Retinal fundus photograph; 2352x1568px
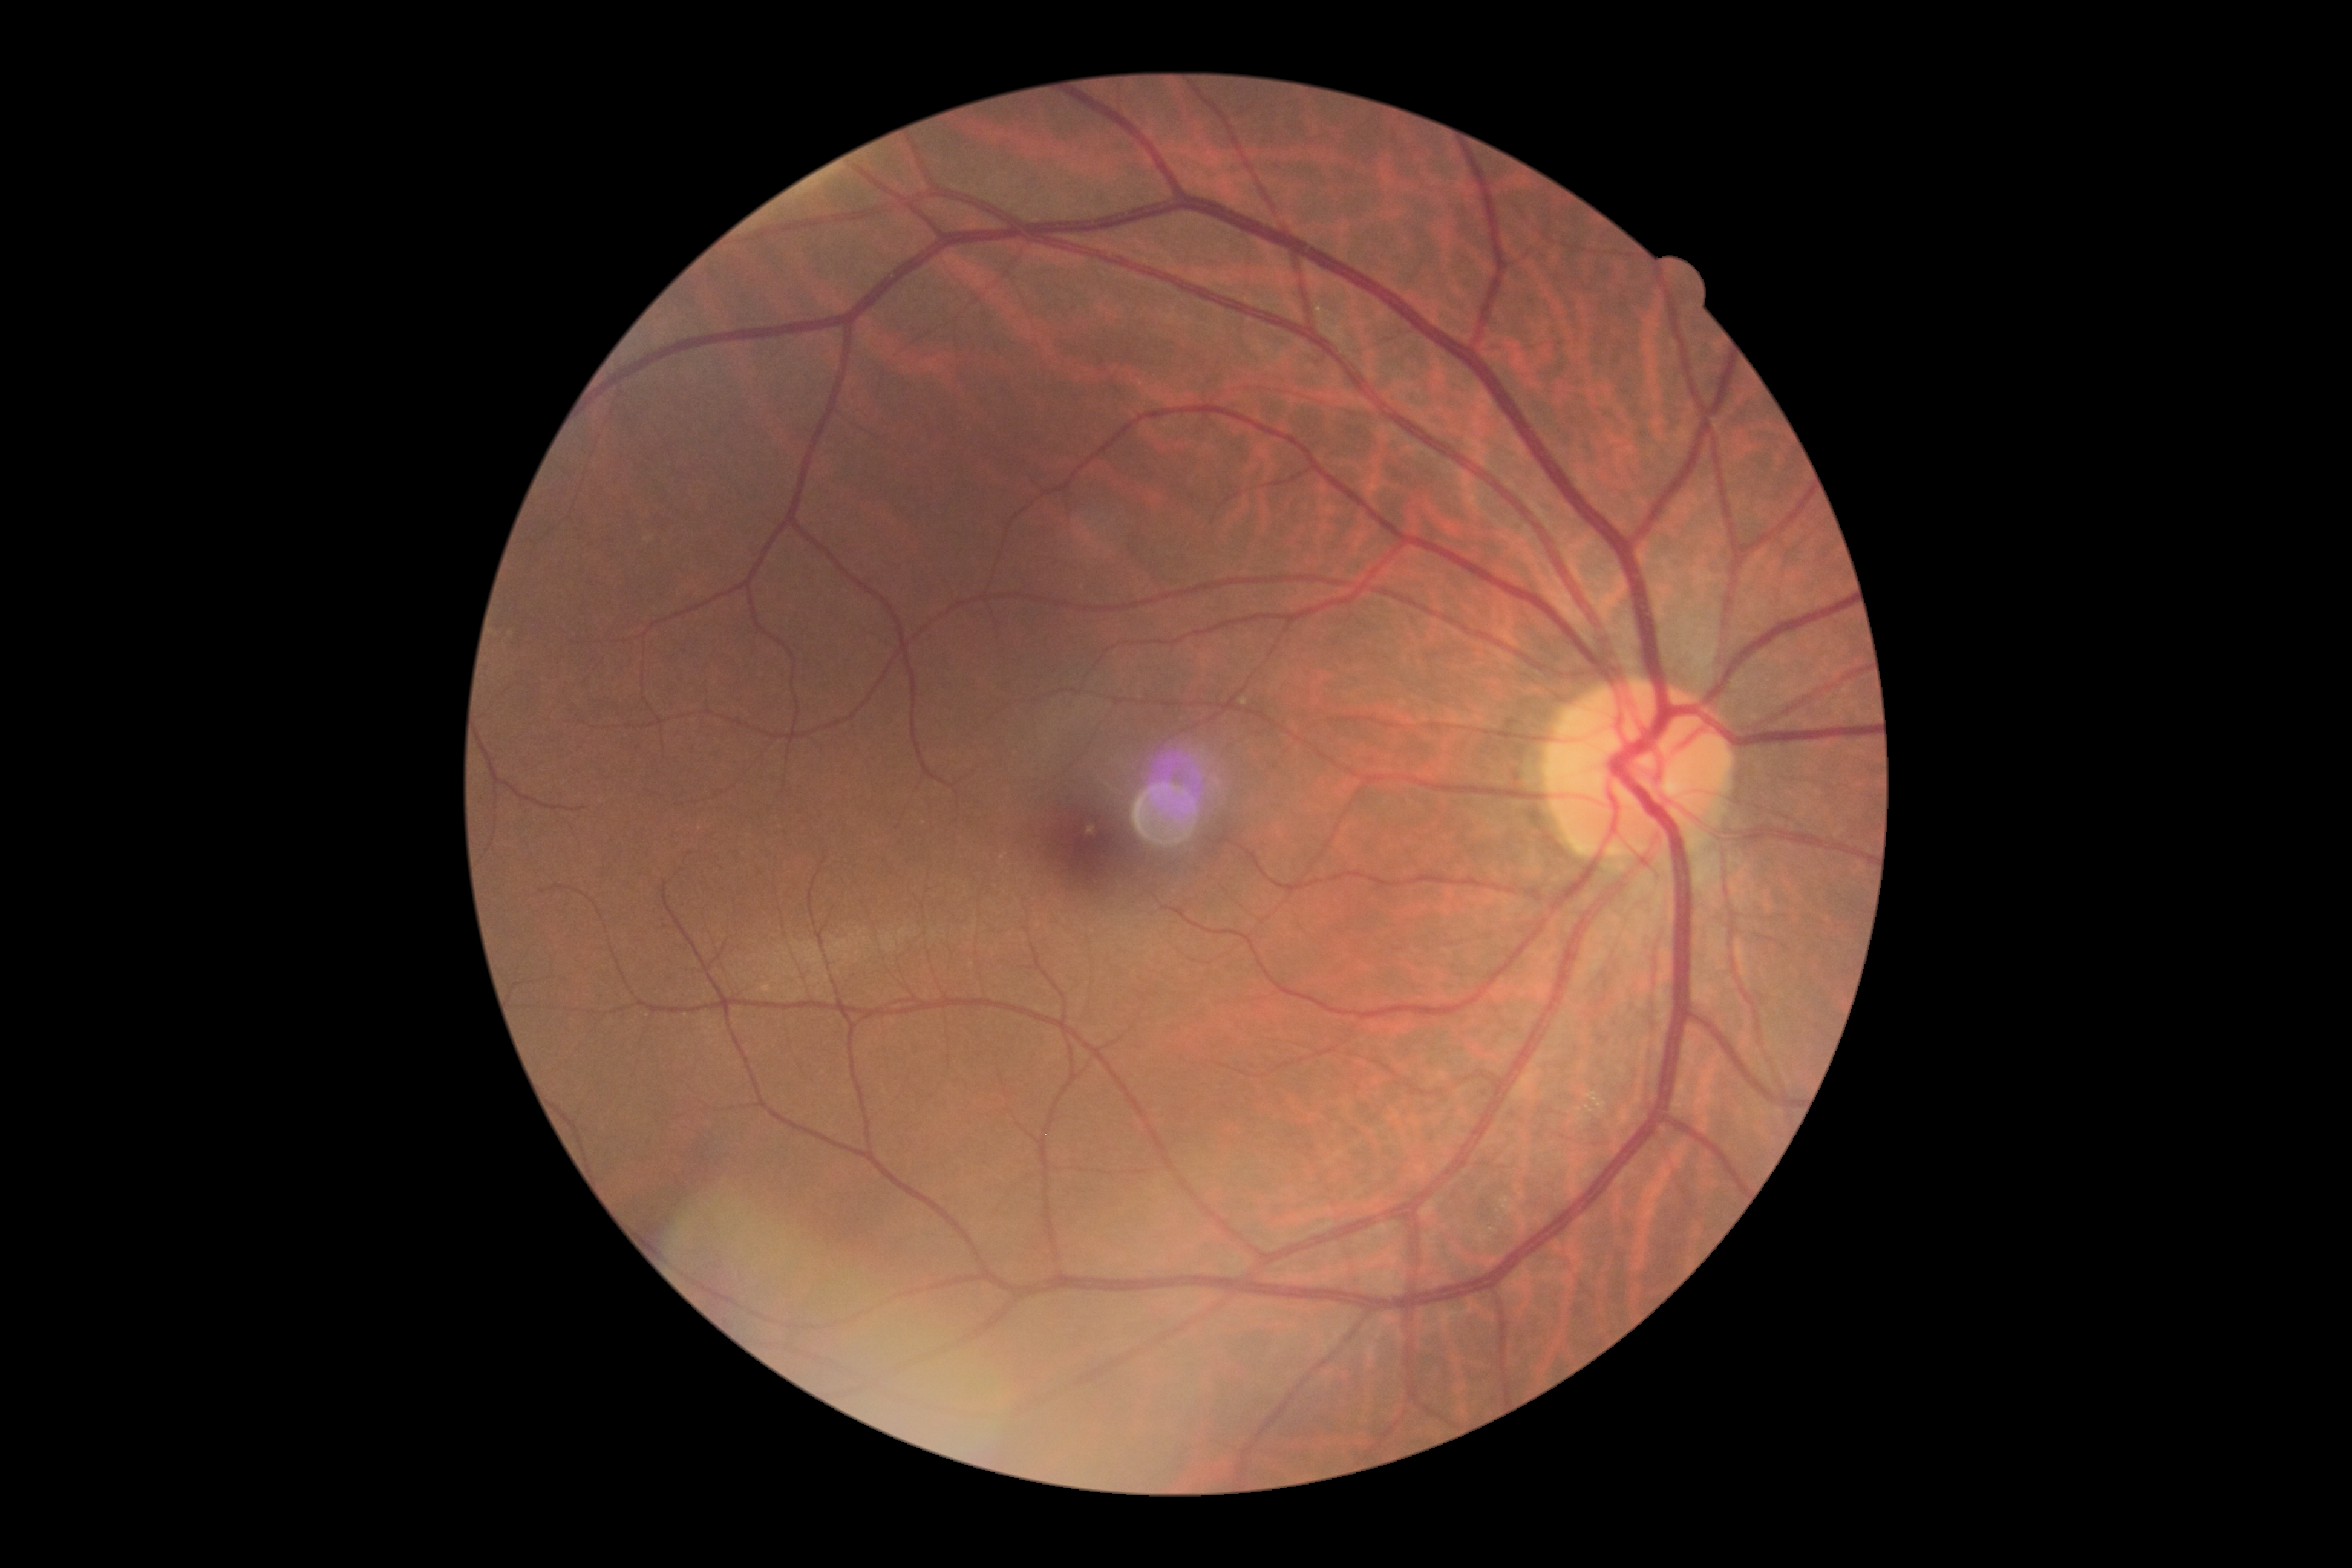 Diabetic retinopathy grade is no apparent diabetic retinopathy (0) — no visible signs of diabetic retinopathy.